50-degree field of view · captured on a Topcon TRC-NW8 fundus camera · macula-centered:
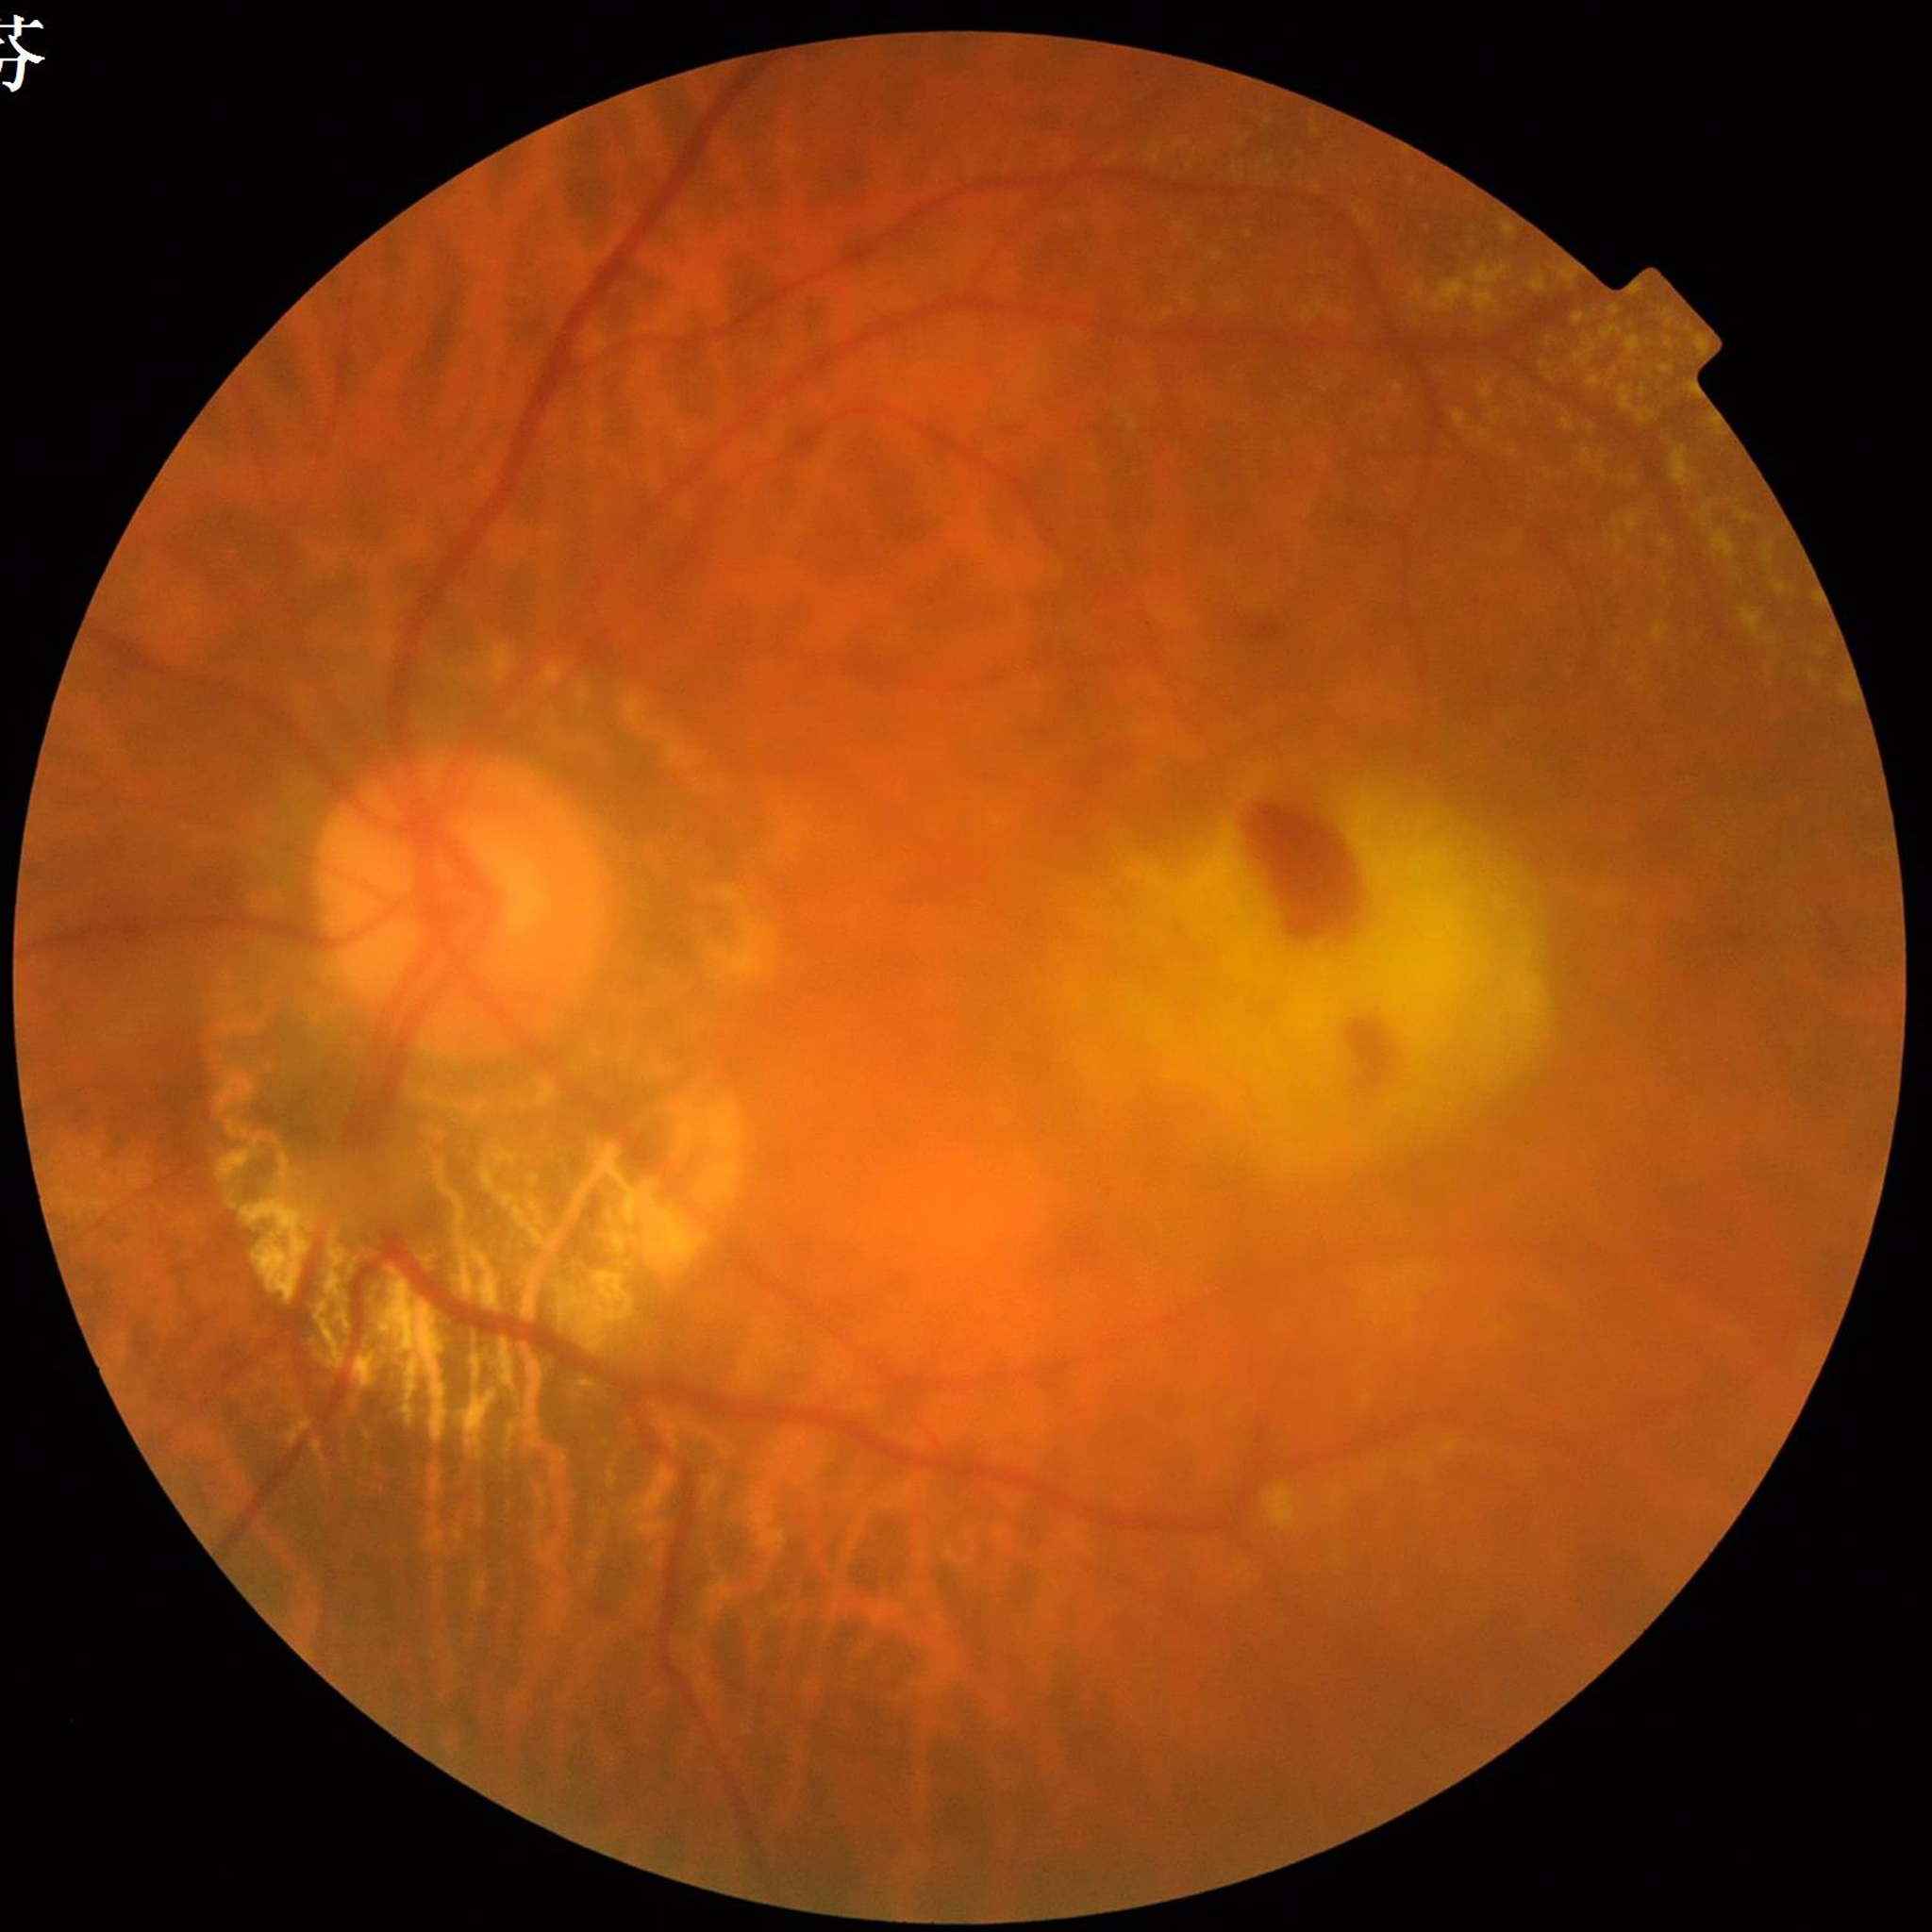

Disease class: age-related macular degeneration.